2212x1672: 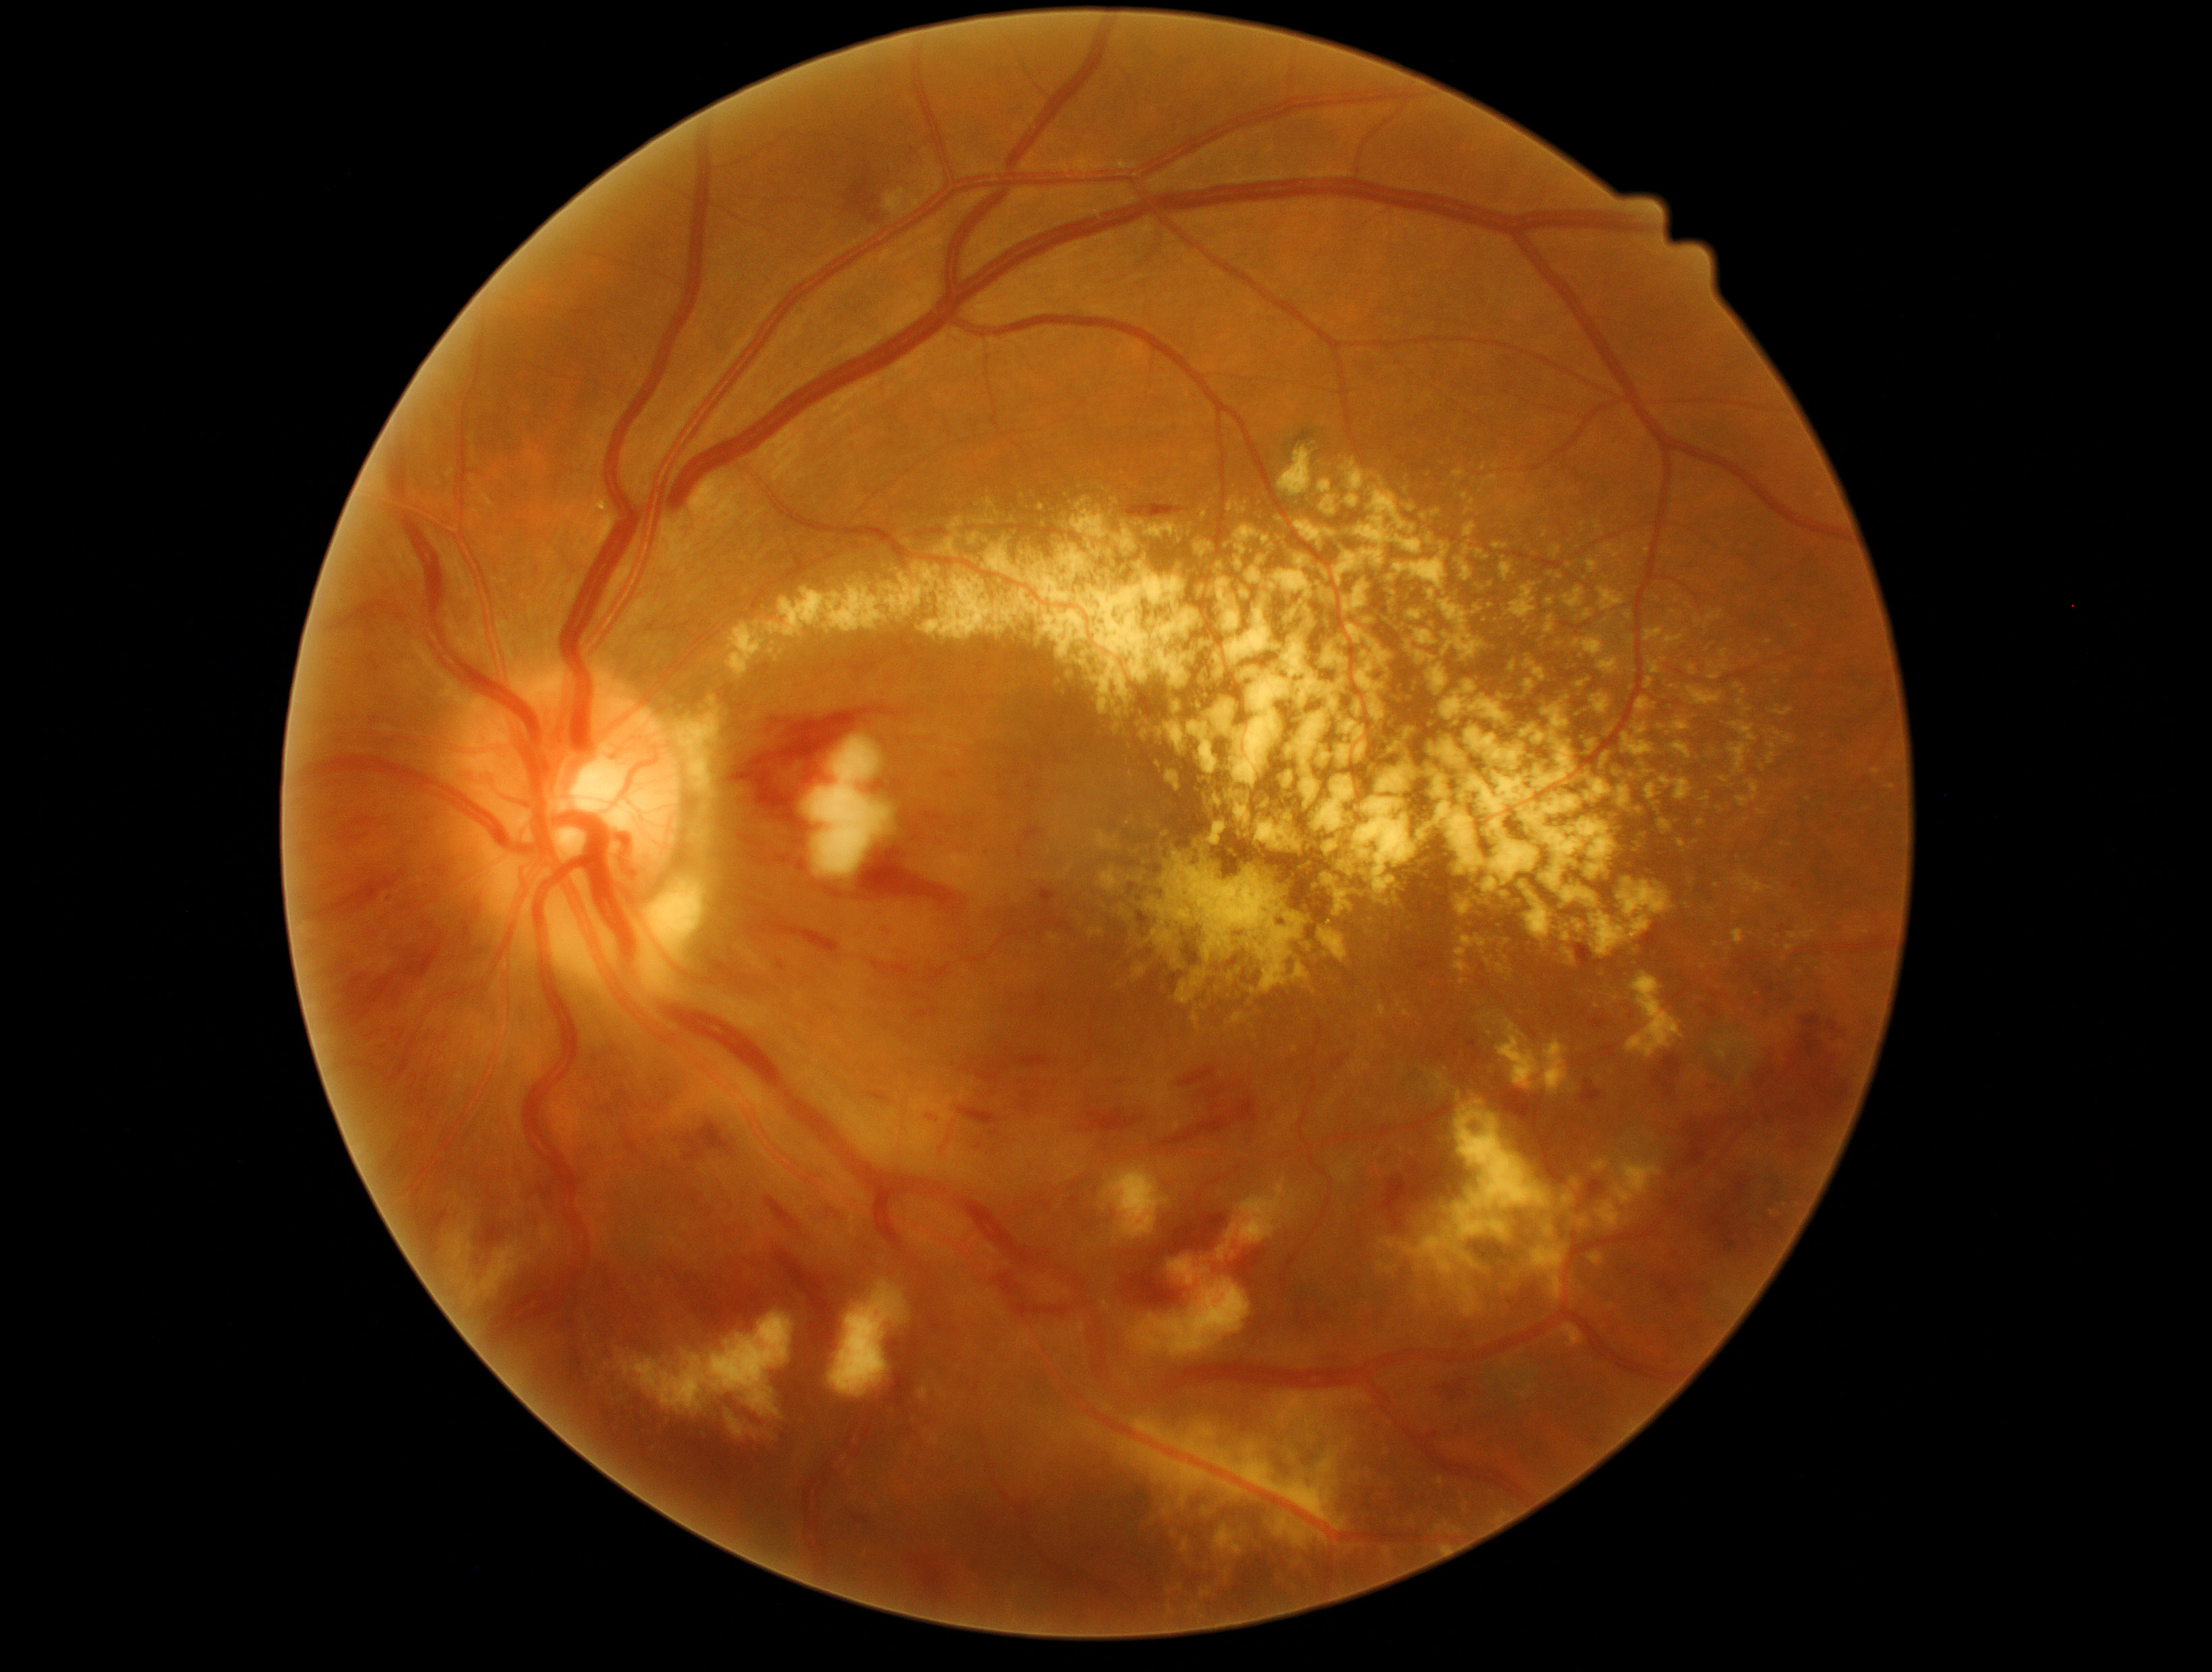

partial: true
dr_grade: 3
dr_grade_name: severe NPDR
lesions:
  he:
    - [1706, 1212, 1759, 1253]
    - [434, 865, 447, 880]
    - [1016, 825, 1045, 861]
    - [1778, 927, 1785, 935]
    - [1710, 992, 1724, 1001]
    - [1737, 1172, 1757, 1198]
    - [969, 903, 1034, 926]
    - [1433, 1380, 1471, 1402]
    - [1376, 1156, 1464, 1234]
    - [810, 881, 844, 899]
    - [1417, 957, 1437, 969]
    - [1233, 1249, 1266, 1287]
    - [1683, 1120, 1719, 1168]
    - [1425, 1044, 1445, 1061]
    - [744, 916, 842, 957]
    - [424, 1074, 432, 1085]
    - [399, 1155, 417, 1174]
  he_small_centers:
    - (617; 1075)
  ex:
    - [702, 803, 711, 819]
    - [1733, 930, 1745, 946]
    - [1784, 736, 1795, 744]
    - [1576, 674, 1592, 691]
    - [1399, 1100, 1556, 1279]
    - [1888, 784, 1896, 791]
    - [1256, 795, 1305, 860]
    - [1507, 579, 1542, 614]
    - [1592, 691, 1611, 722]
    - [637, 877, 707, 998]
    - [981, 517, 996, 533]
    - [1460, 1286, 1483, 1318]
    - [1405, 854, 1433, 888]
    - [1716, 802, 1726, 814]
    - [1291, 963, 1310, 982]
    - [1273, 1514, 1329, 1549]
    - [1662, 718, 1692, 734]
  ex_small_centers:
    - (1566; 658)
    - (1689; 616)
    - (1612; 1308)